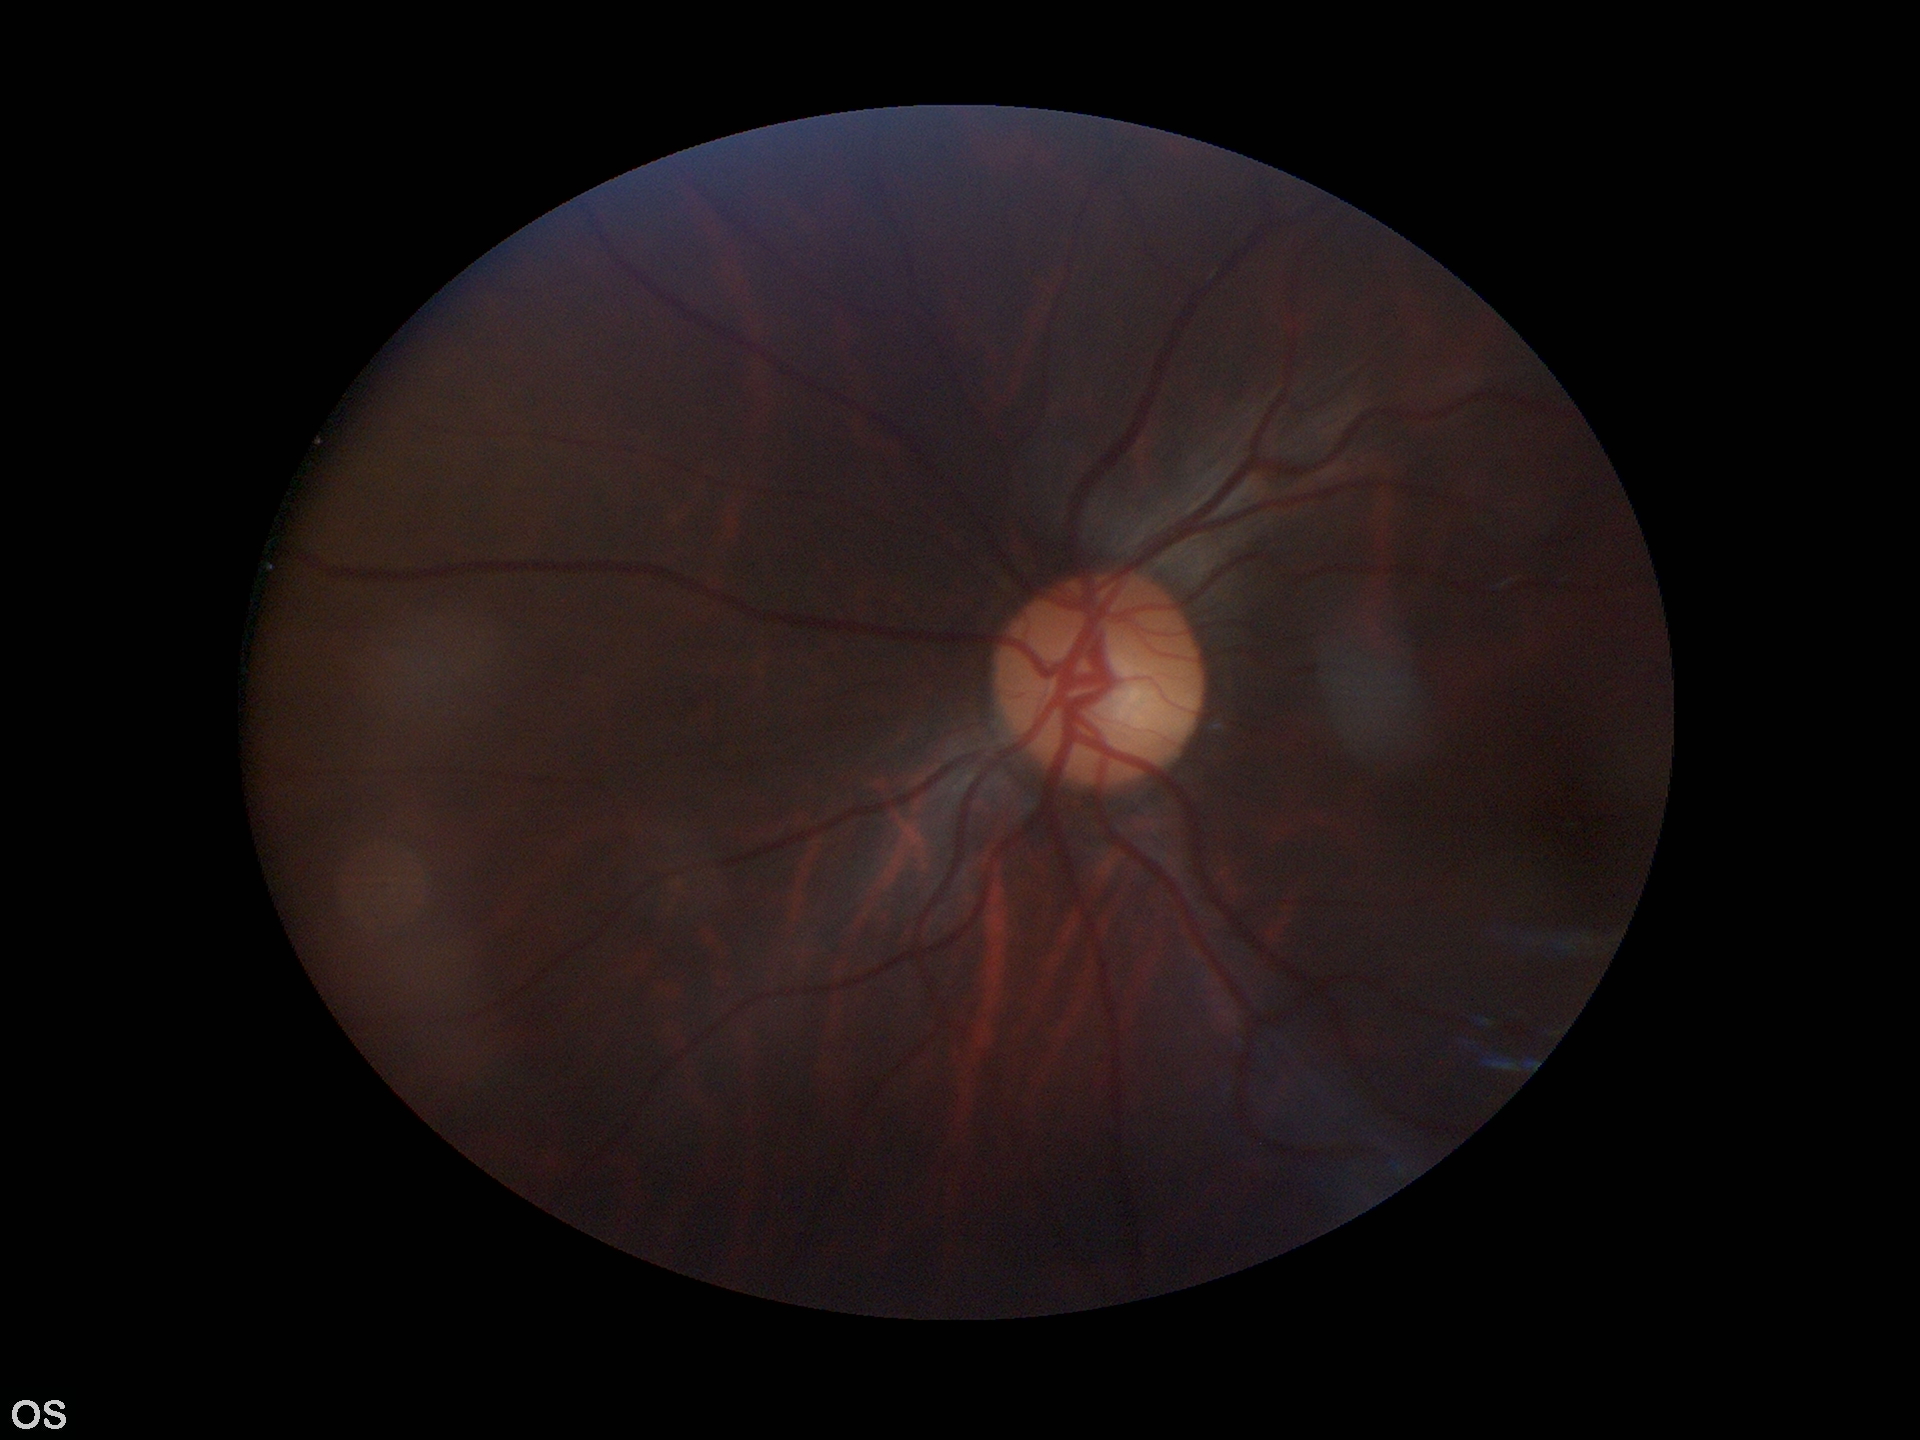
Horizontal CDR (HCDR): 0.50.
No glaucomatous optic neuropathy.
Vertical cup-to-disc ratio (VCDR) of 0.56.